45 degree fundus photograph:
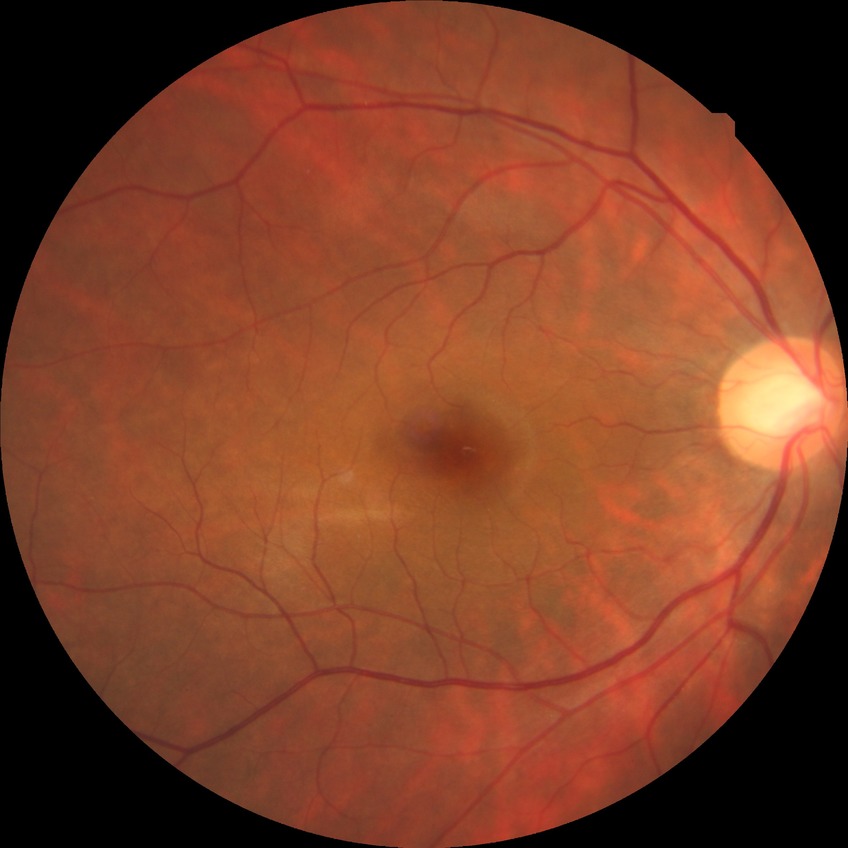

Modified Davis grade: NDR. No apparent diabetic retinopathy.